45° field of view — 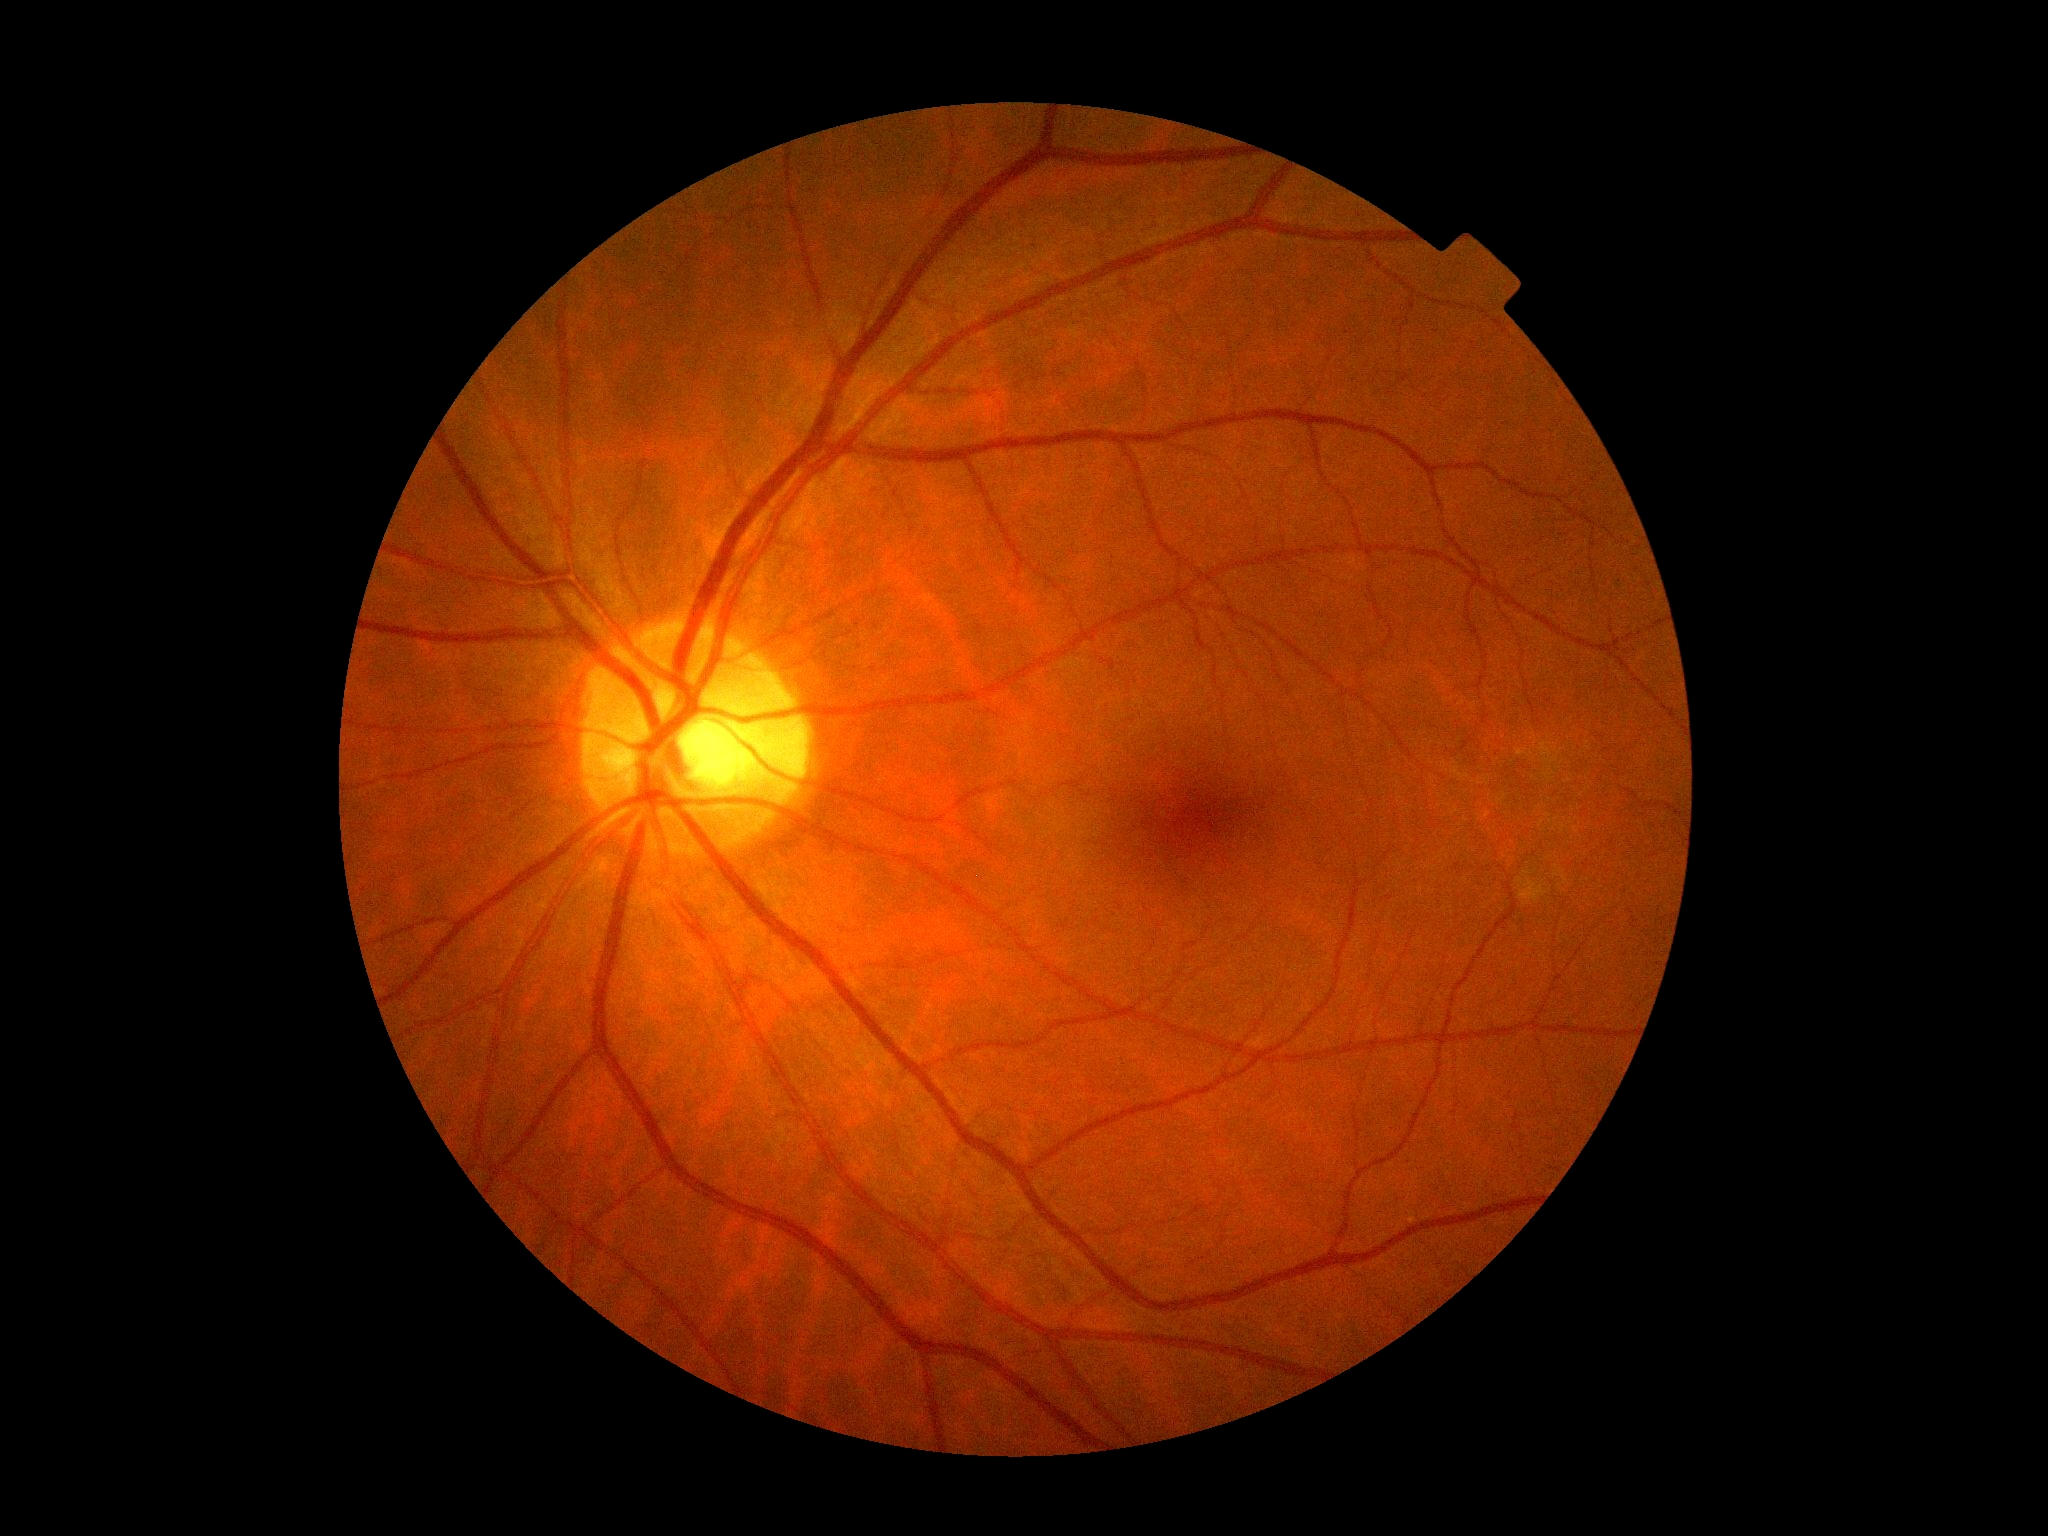
DR severity: no apparent retinopathy (grade 0).